Retinal fundus photograph:
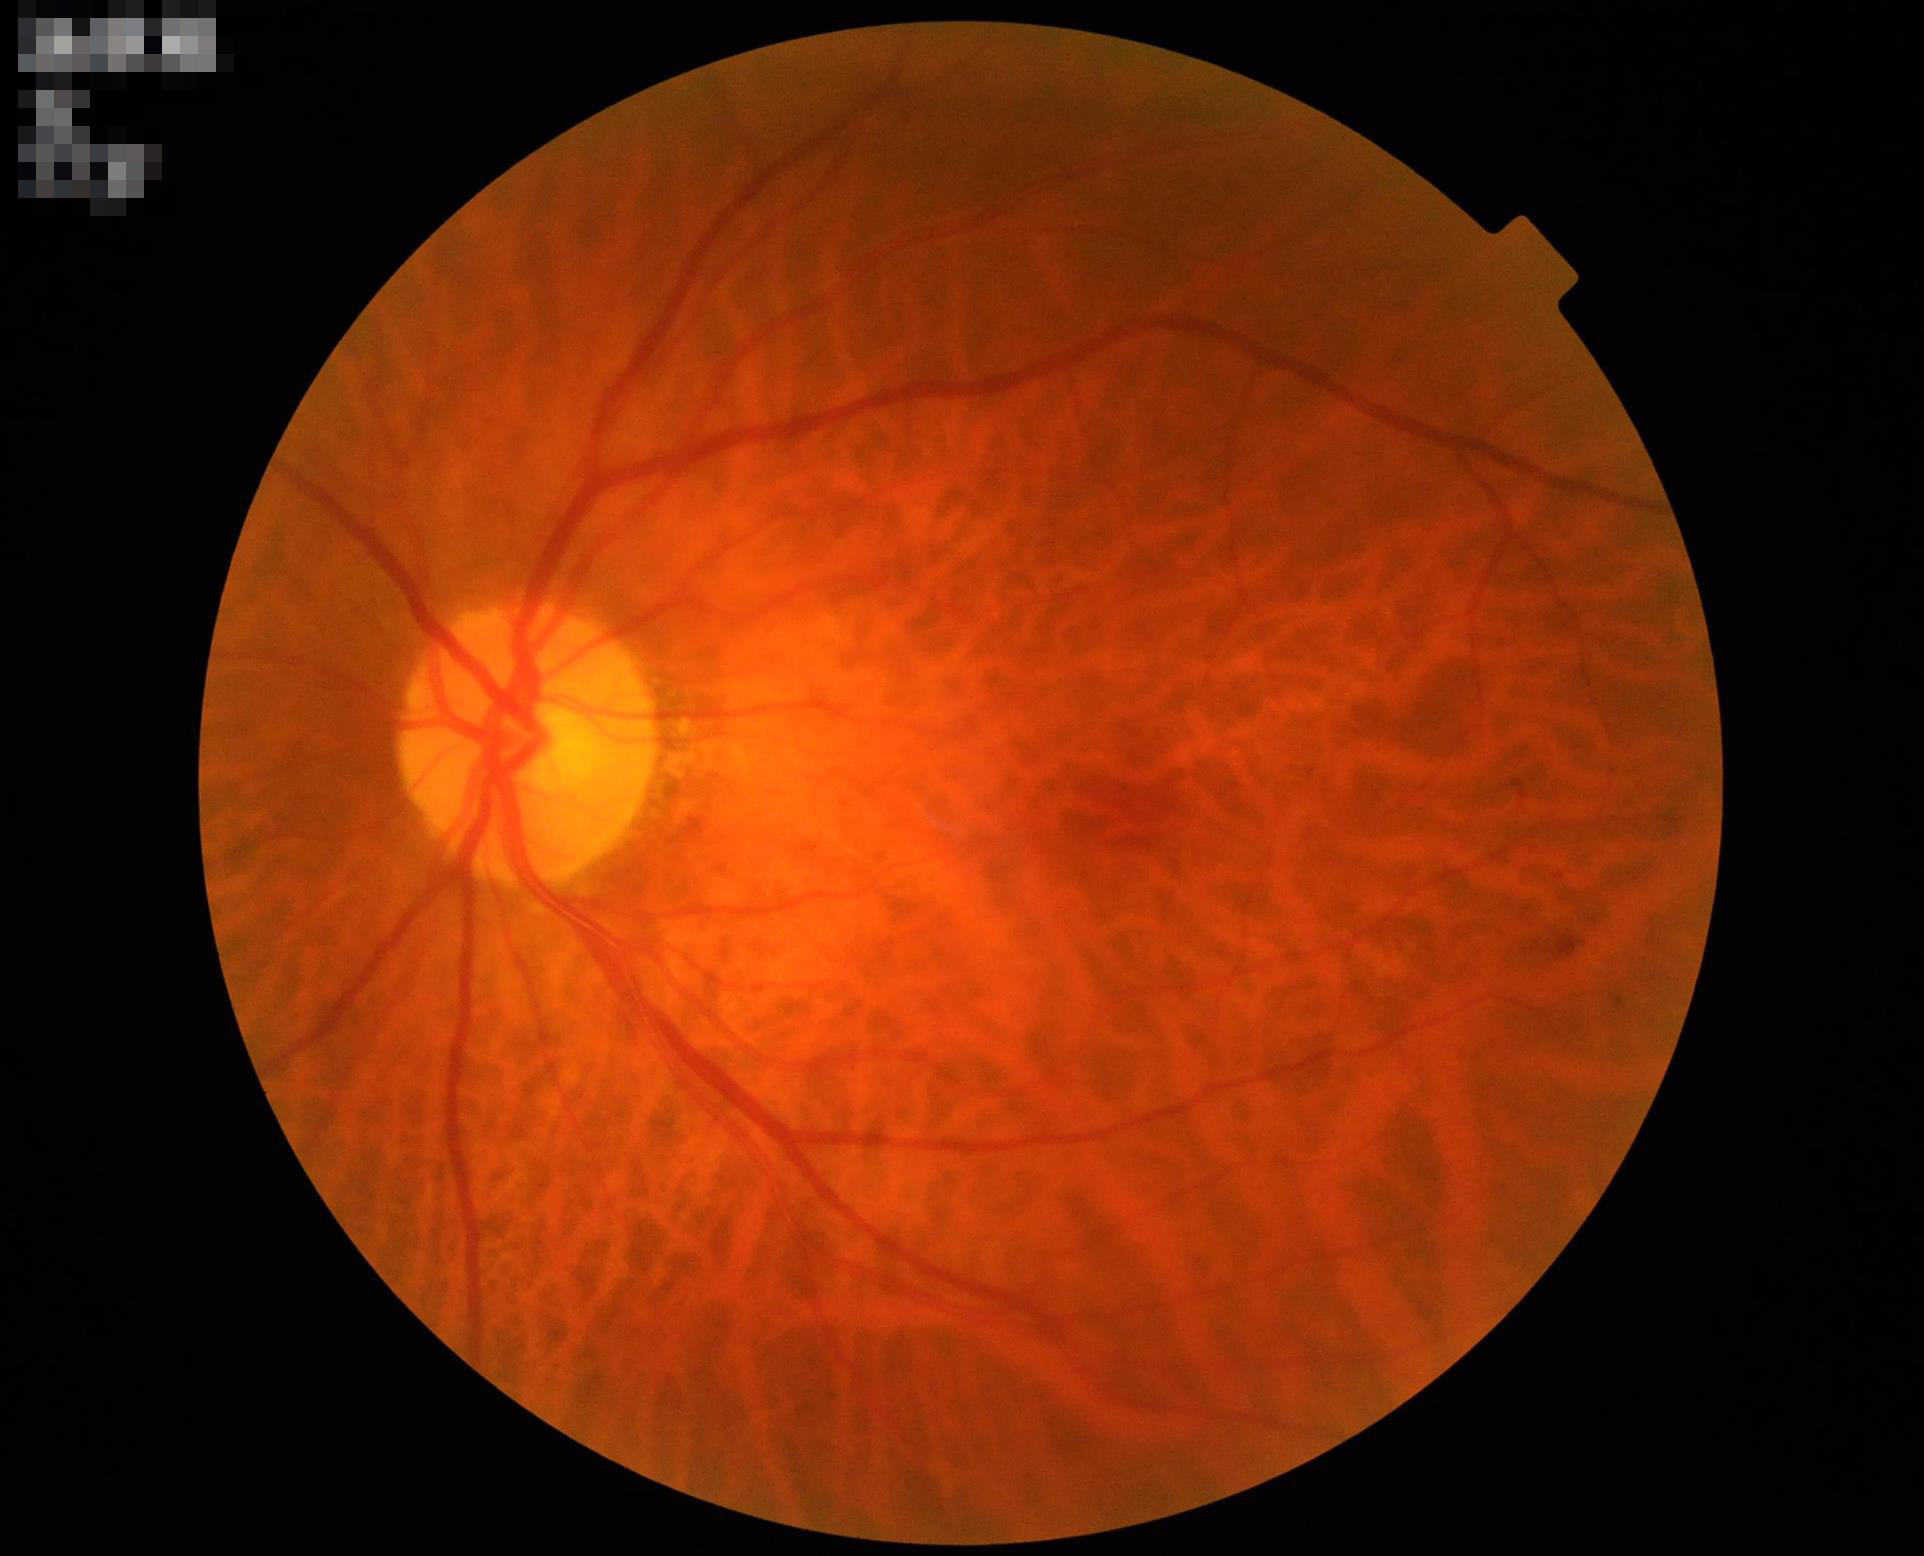

Adequate contrast for distinguishing structures.
No over- or under-exposure.
No noticeable blur.
Acceptable image quality.